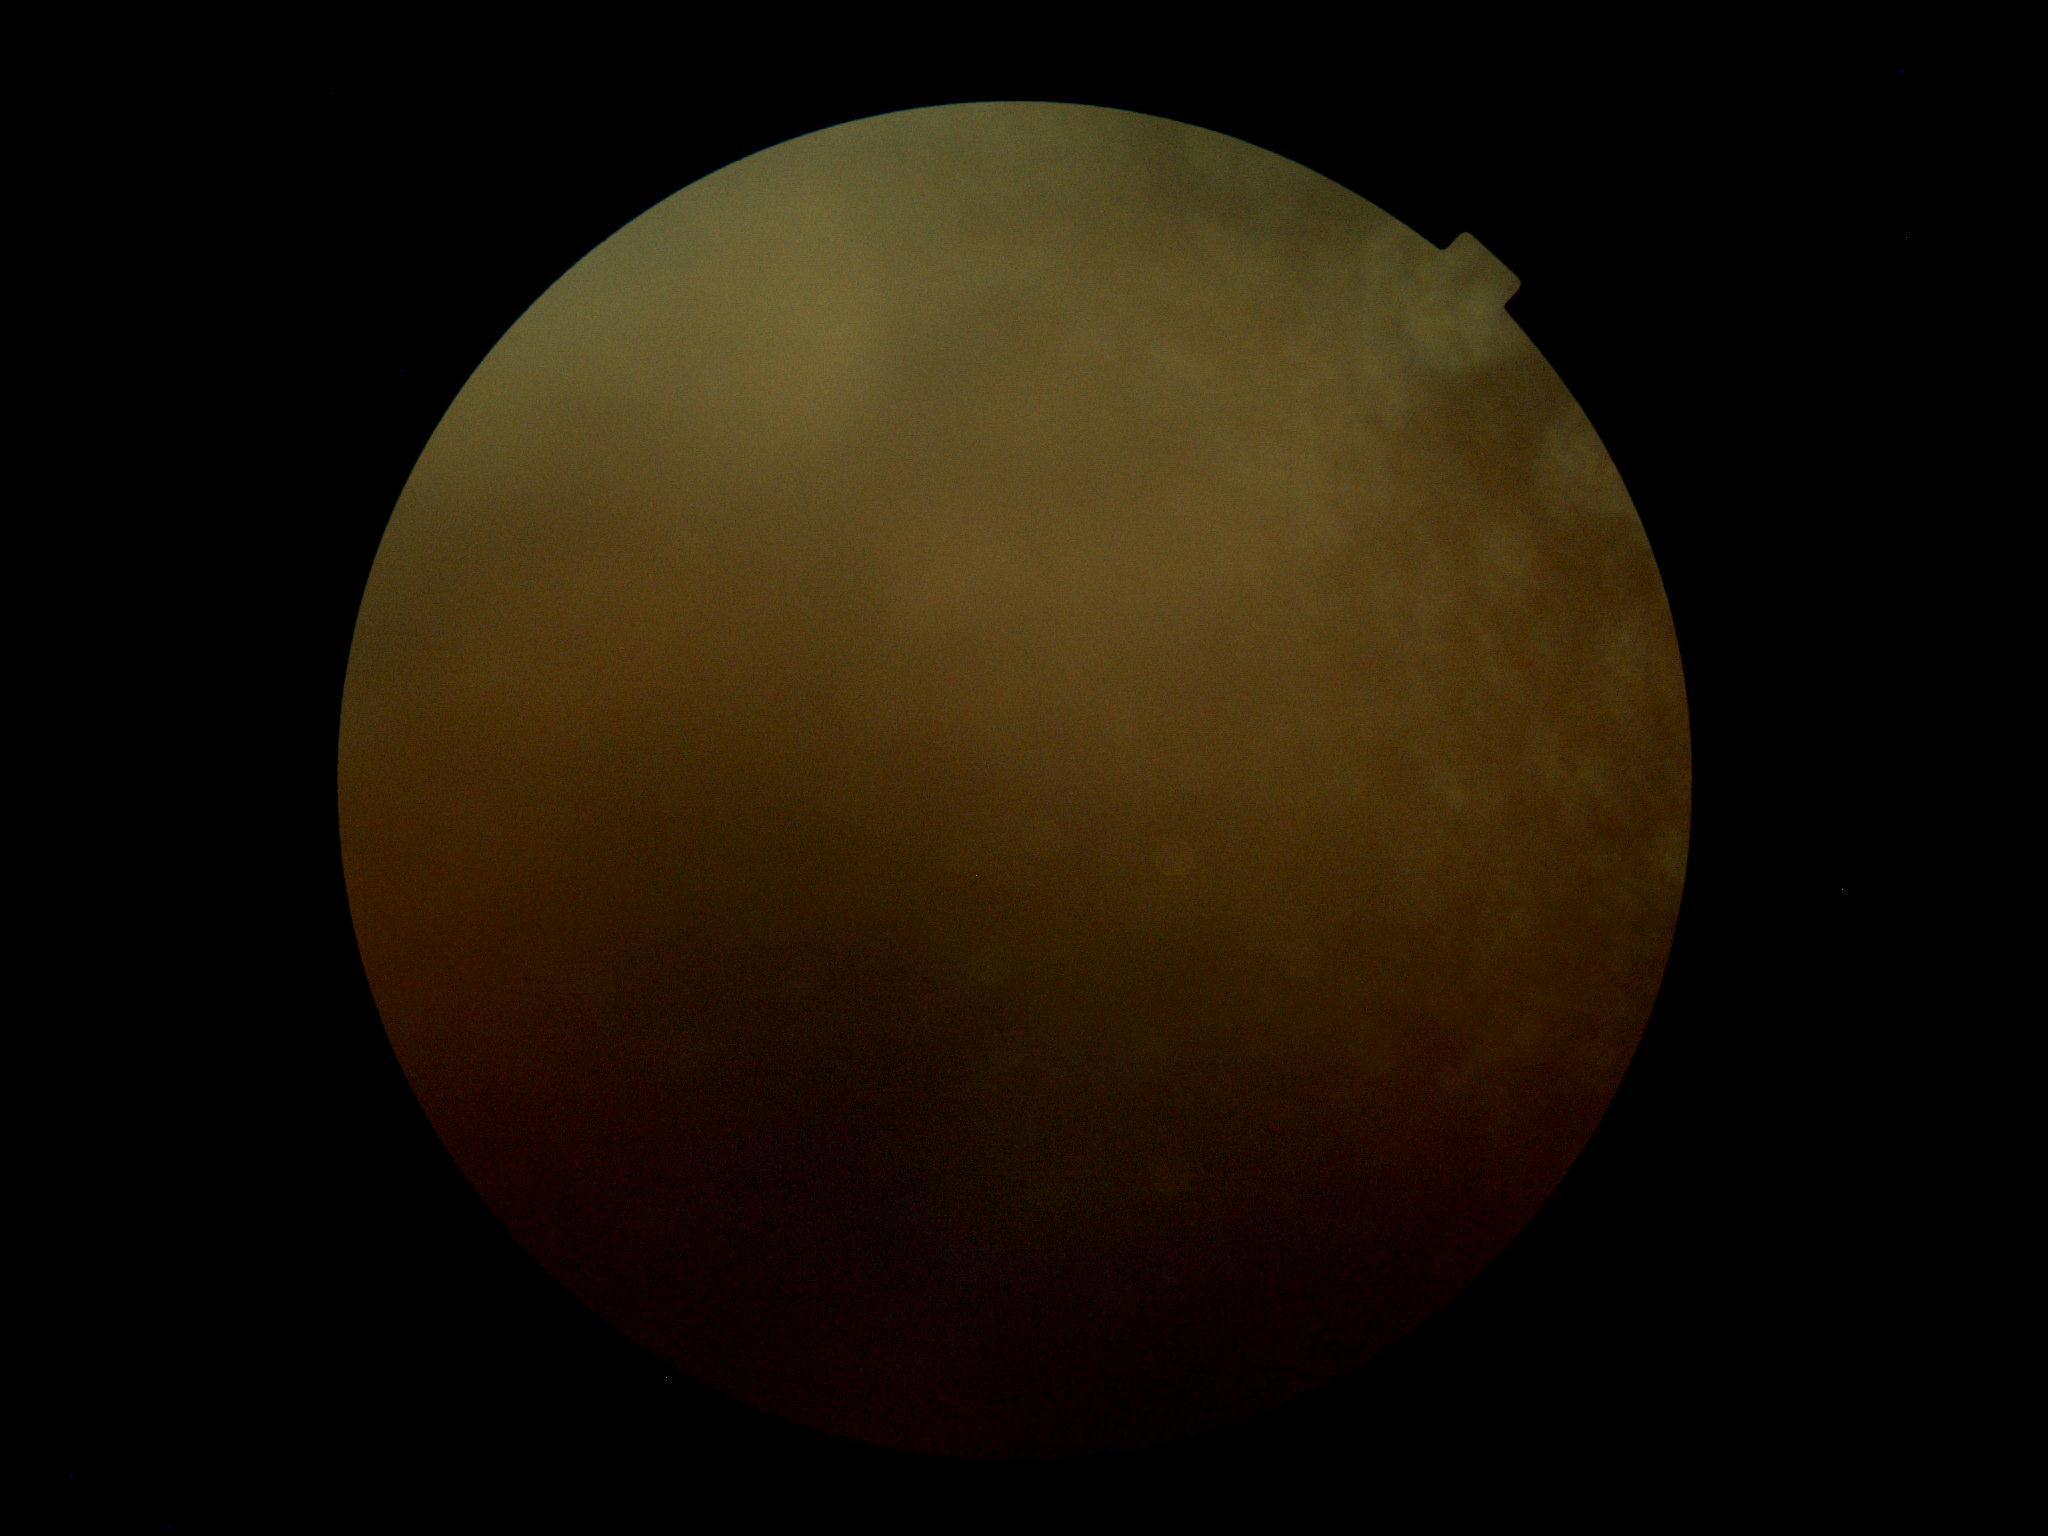
image quality: too poor for DR grading; DR stage: ungradable.